Modified Davis grading — 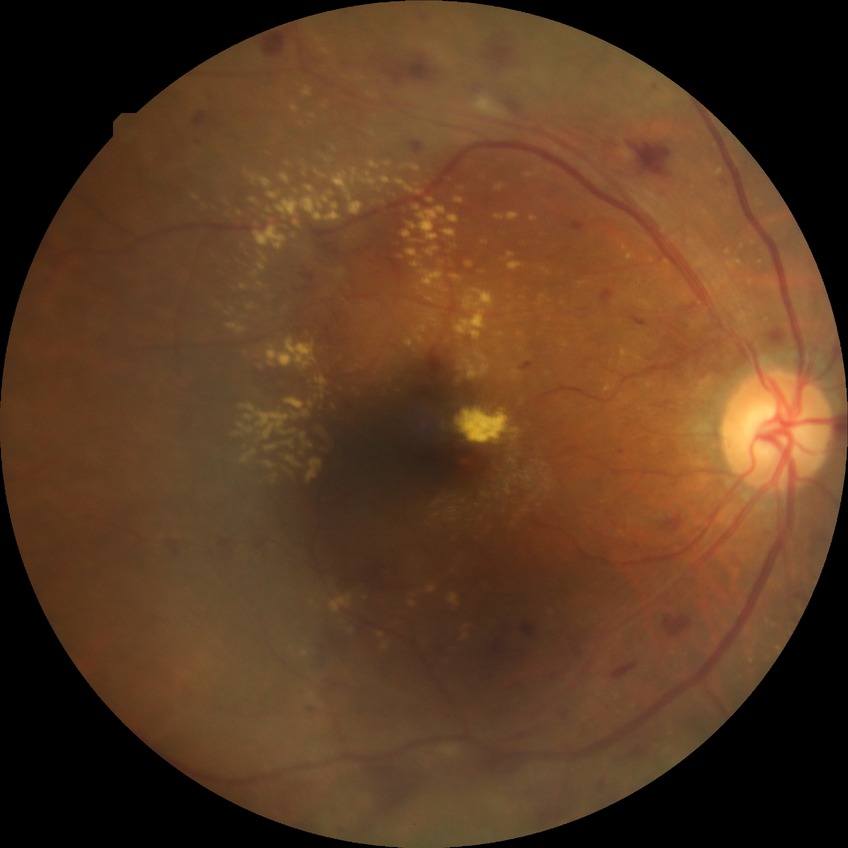
Assessment:
- diabetic retinopathy (DR): pre-proliferative diabetic retinopathy (PPDR)